Tabletop color fundus camera image. Image size 412x310. 45-degree field of view:
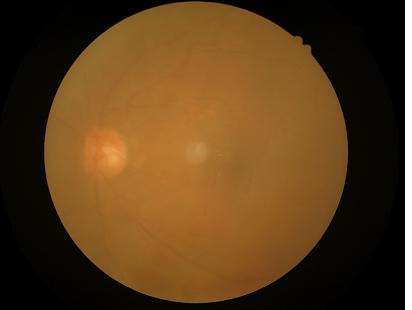
{
  "contrast": "low",
  "clarity": "poor",
  "overall_quality": "poor",
  "illumination": "even"
}